Wide-field fundus photograph from neonatal ROP screening
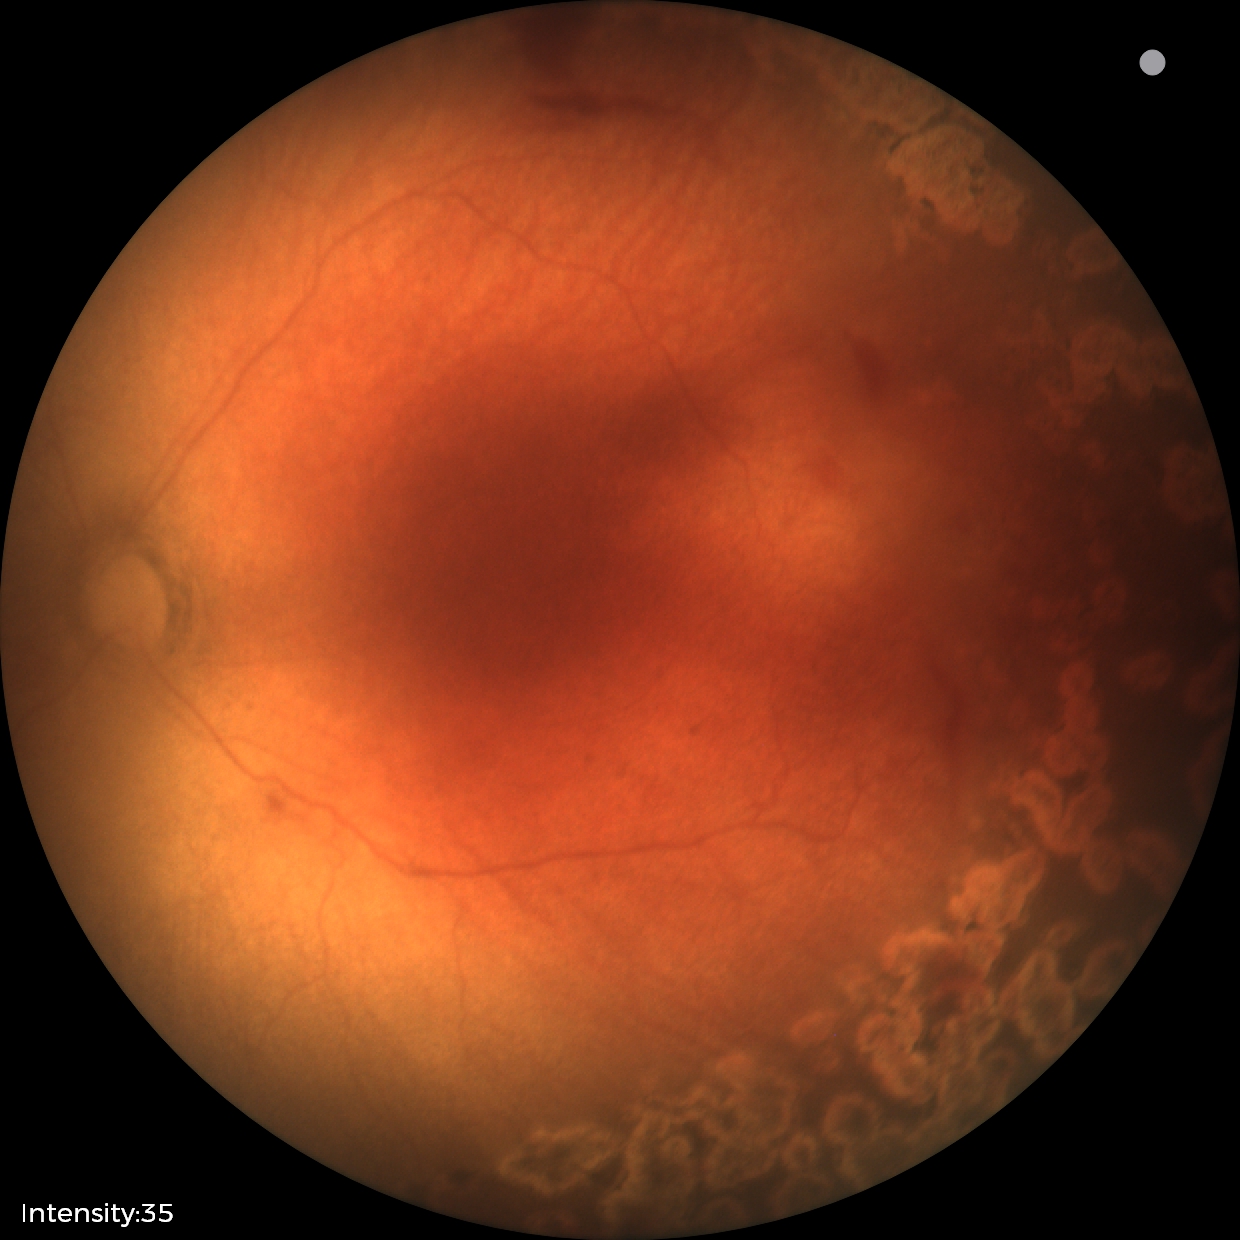

Series diagnosed as status post ROP.